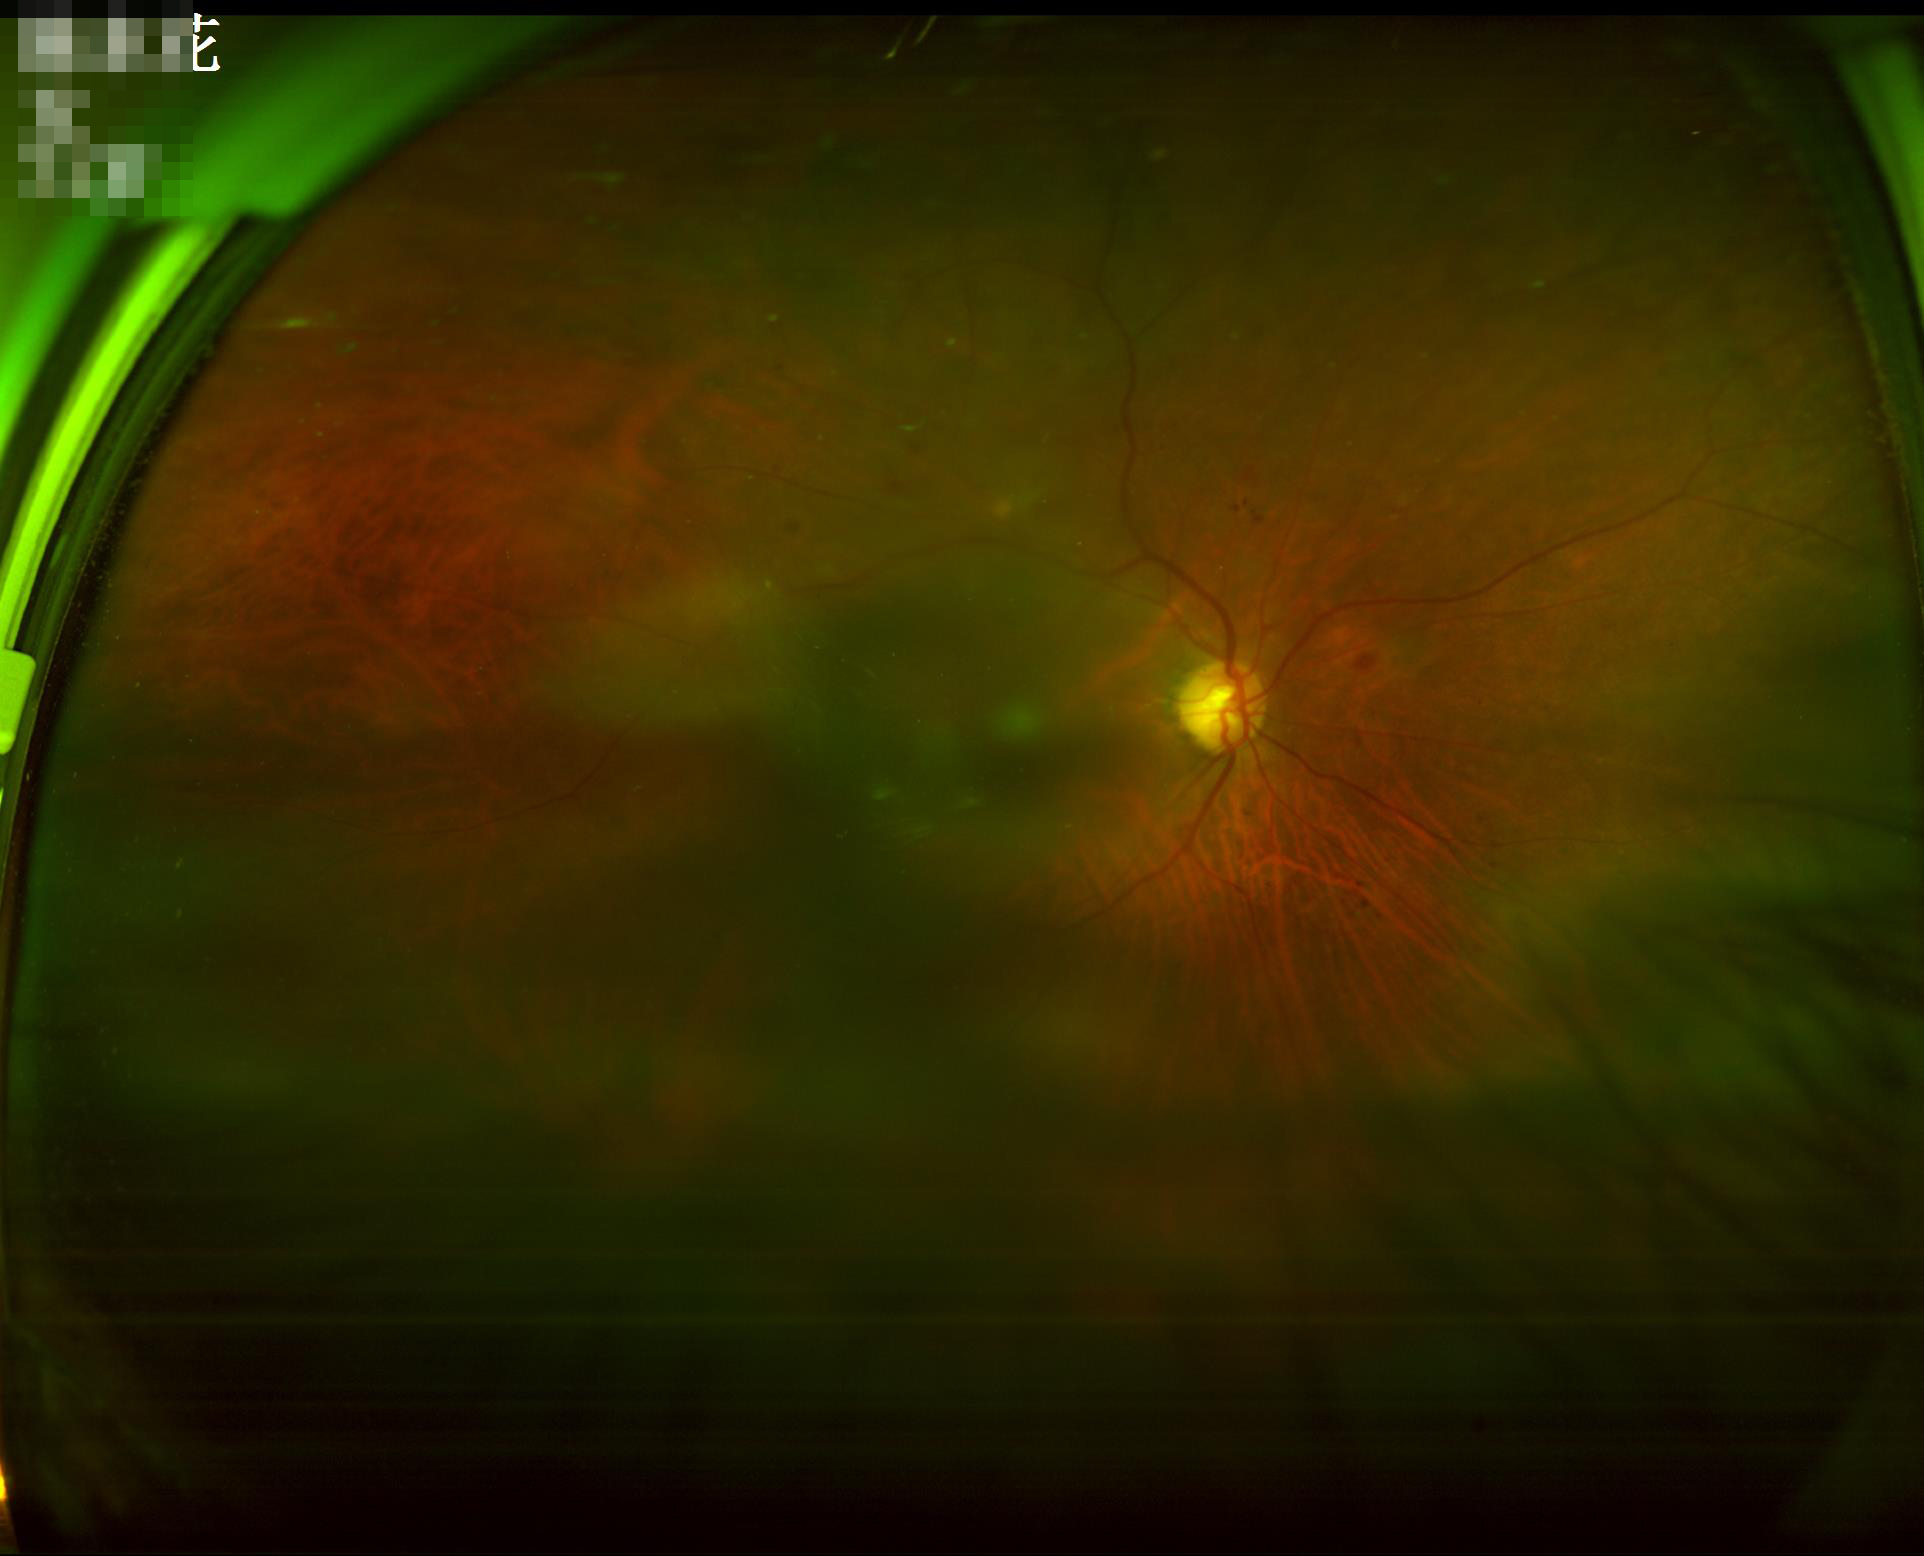

Image quality assessment:
- illumination/color: inadequate, with uneven exposure or color distortion
- overall: poor, ungradable
- focus: reduced sharpness with visible blur